Image size 2089x1764. CFP:
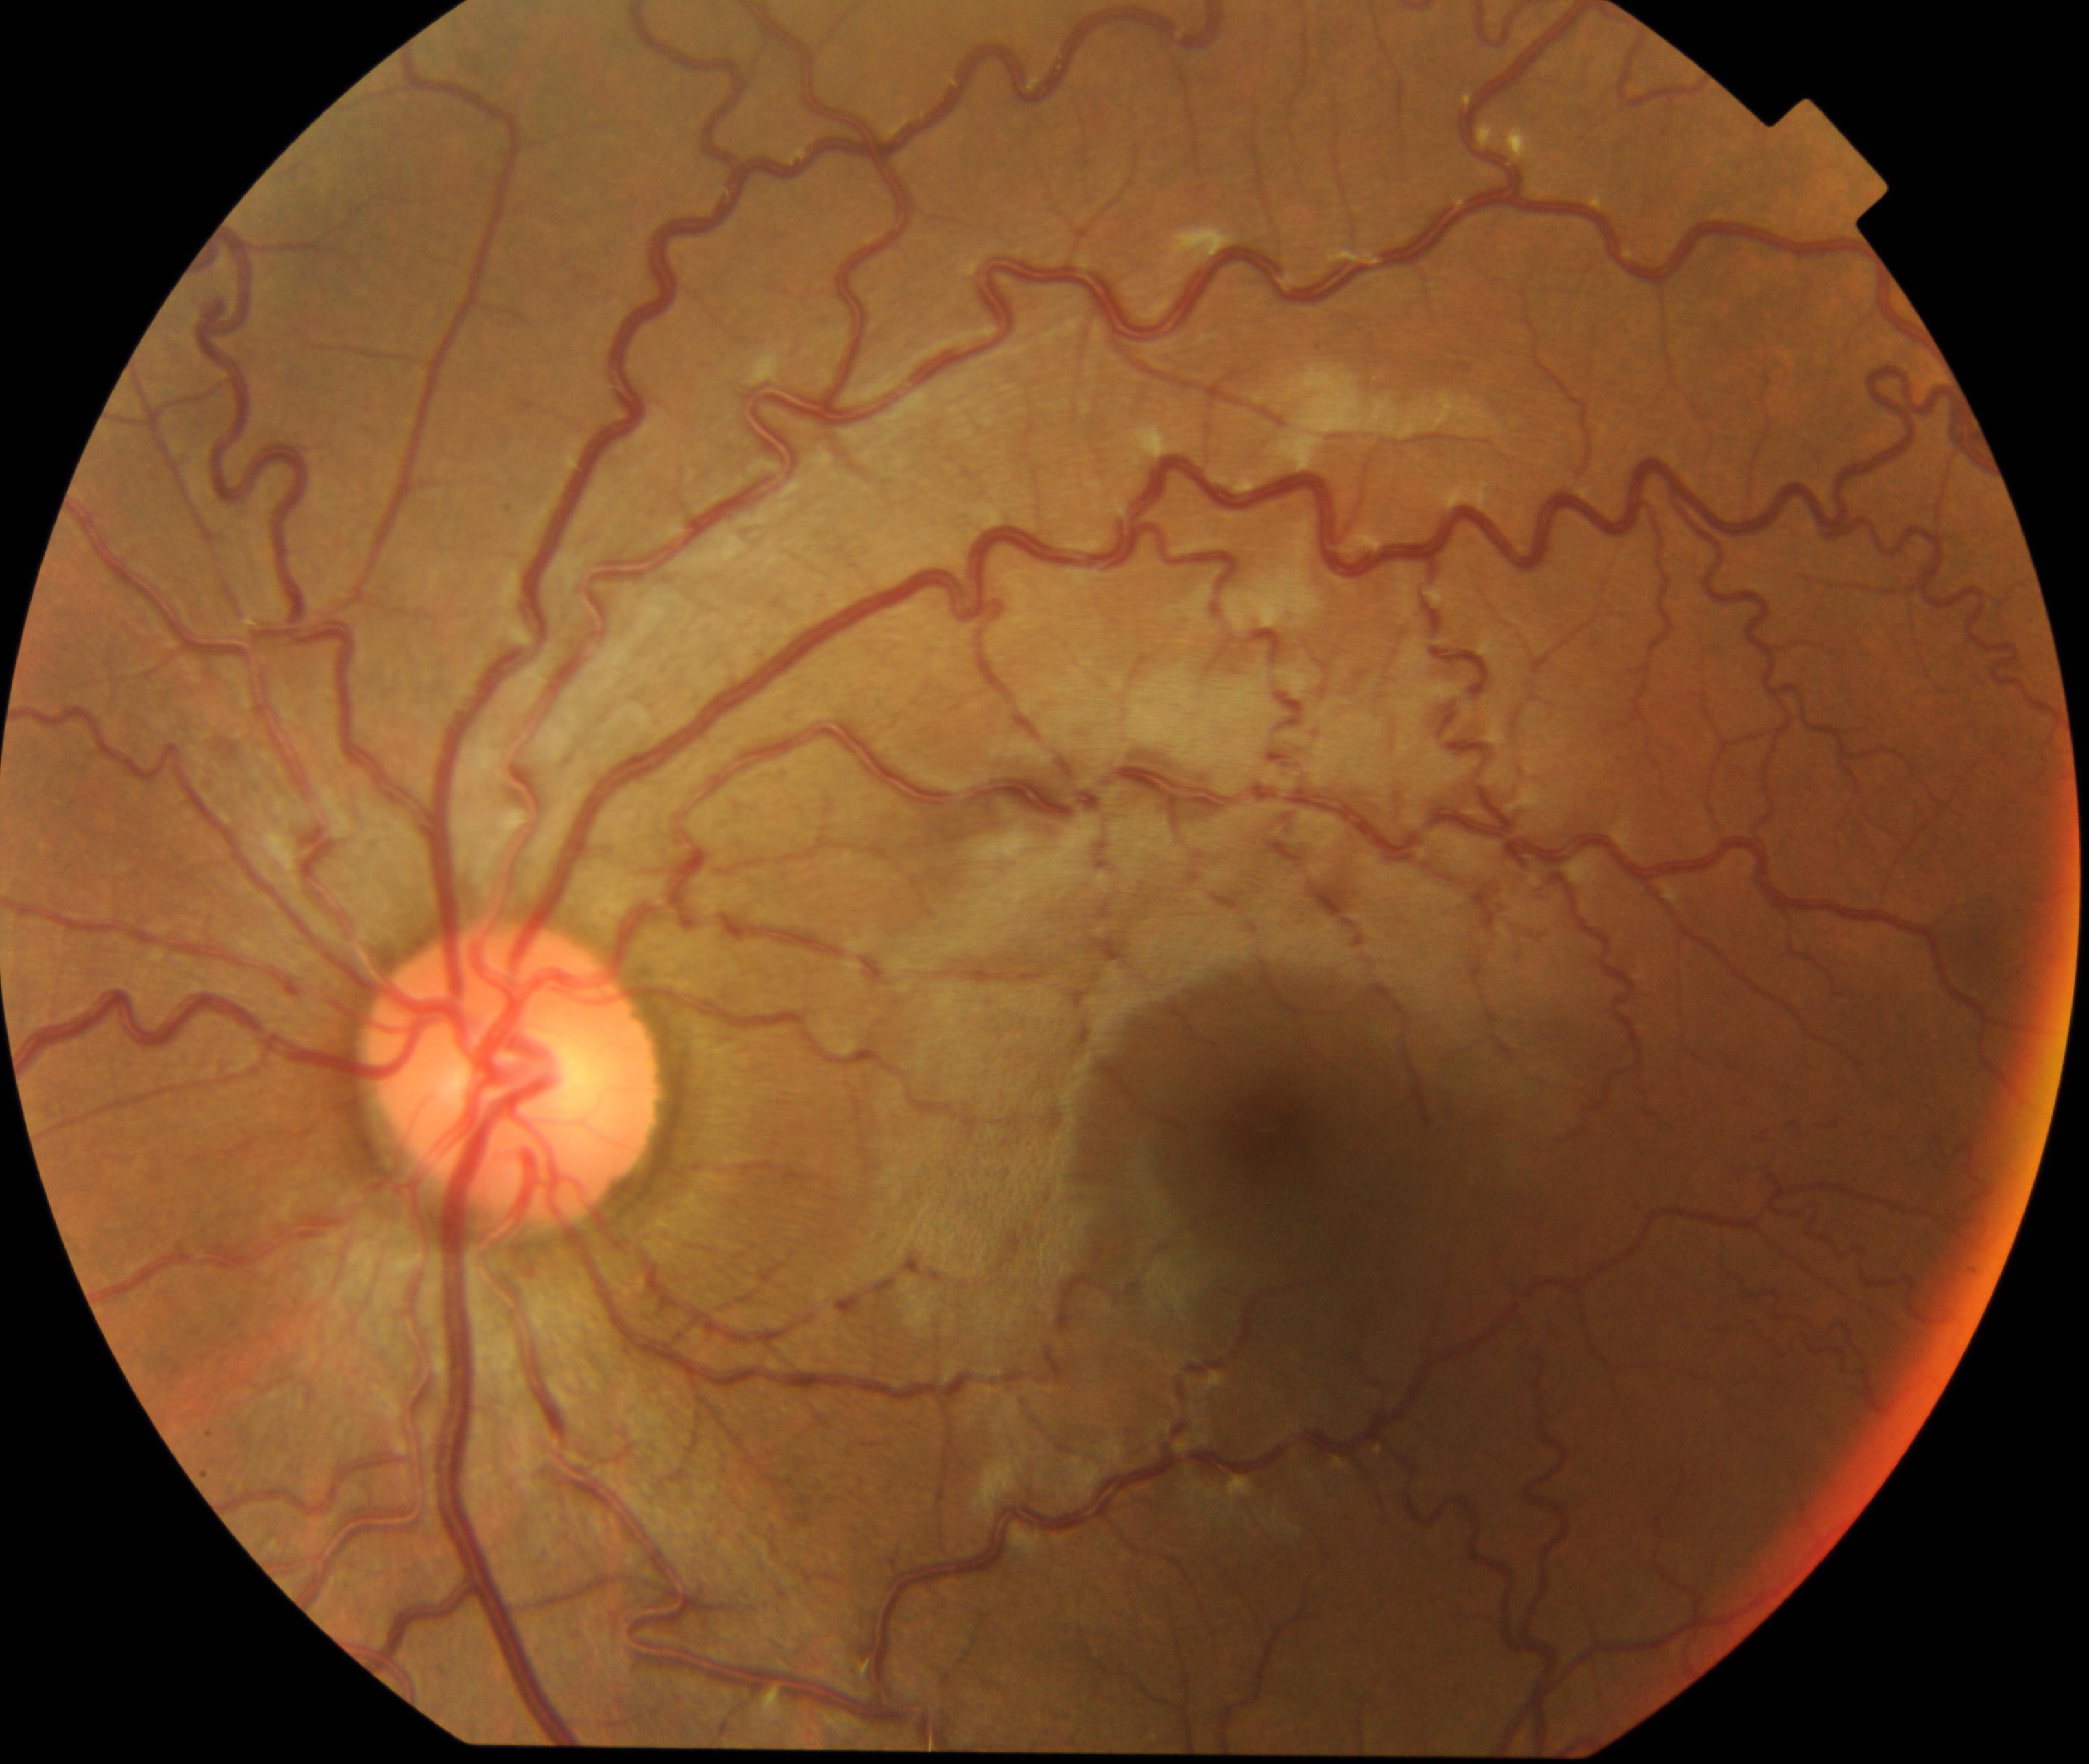

Diagnosis: vessel tortuosity. Features include tortuous and sometimes dilated arteries and veins, locally or across the retina.